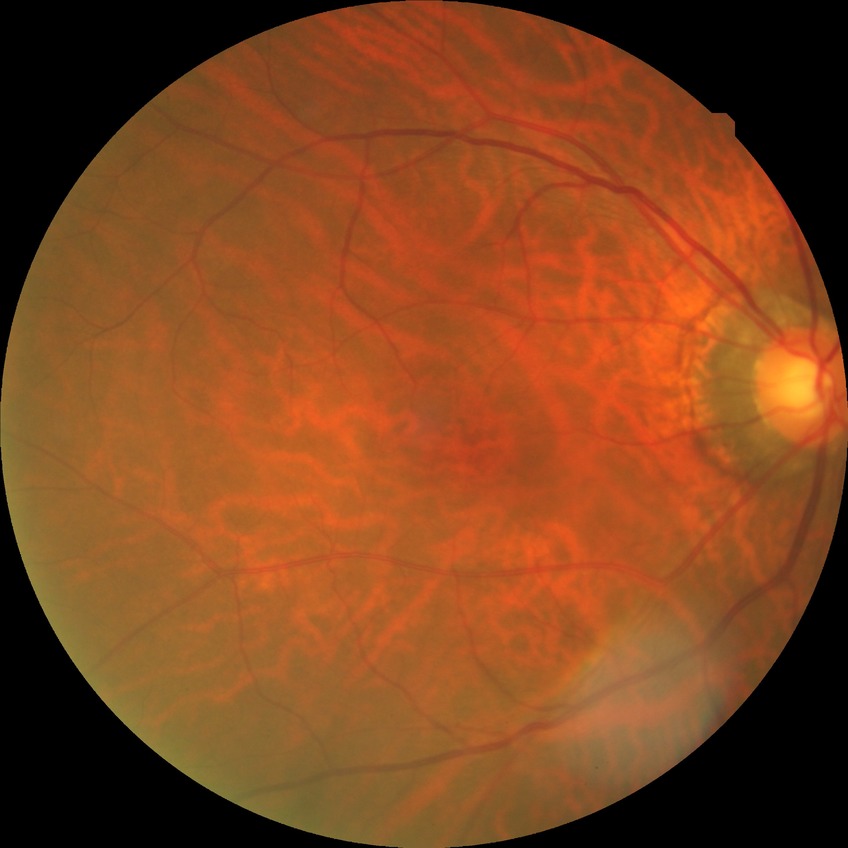
Retinopathy stage is no diabetic retinopathy.